Retinal fundus photograph — 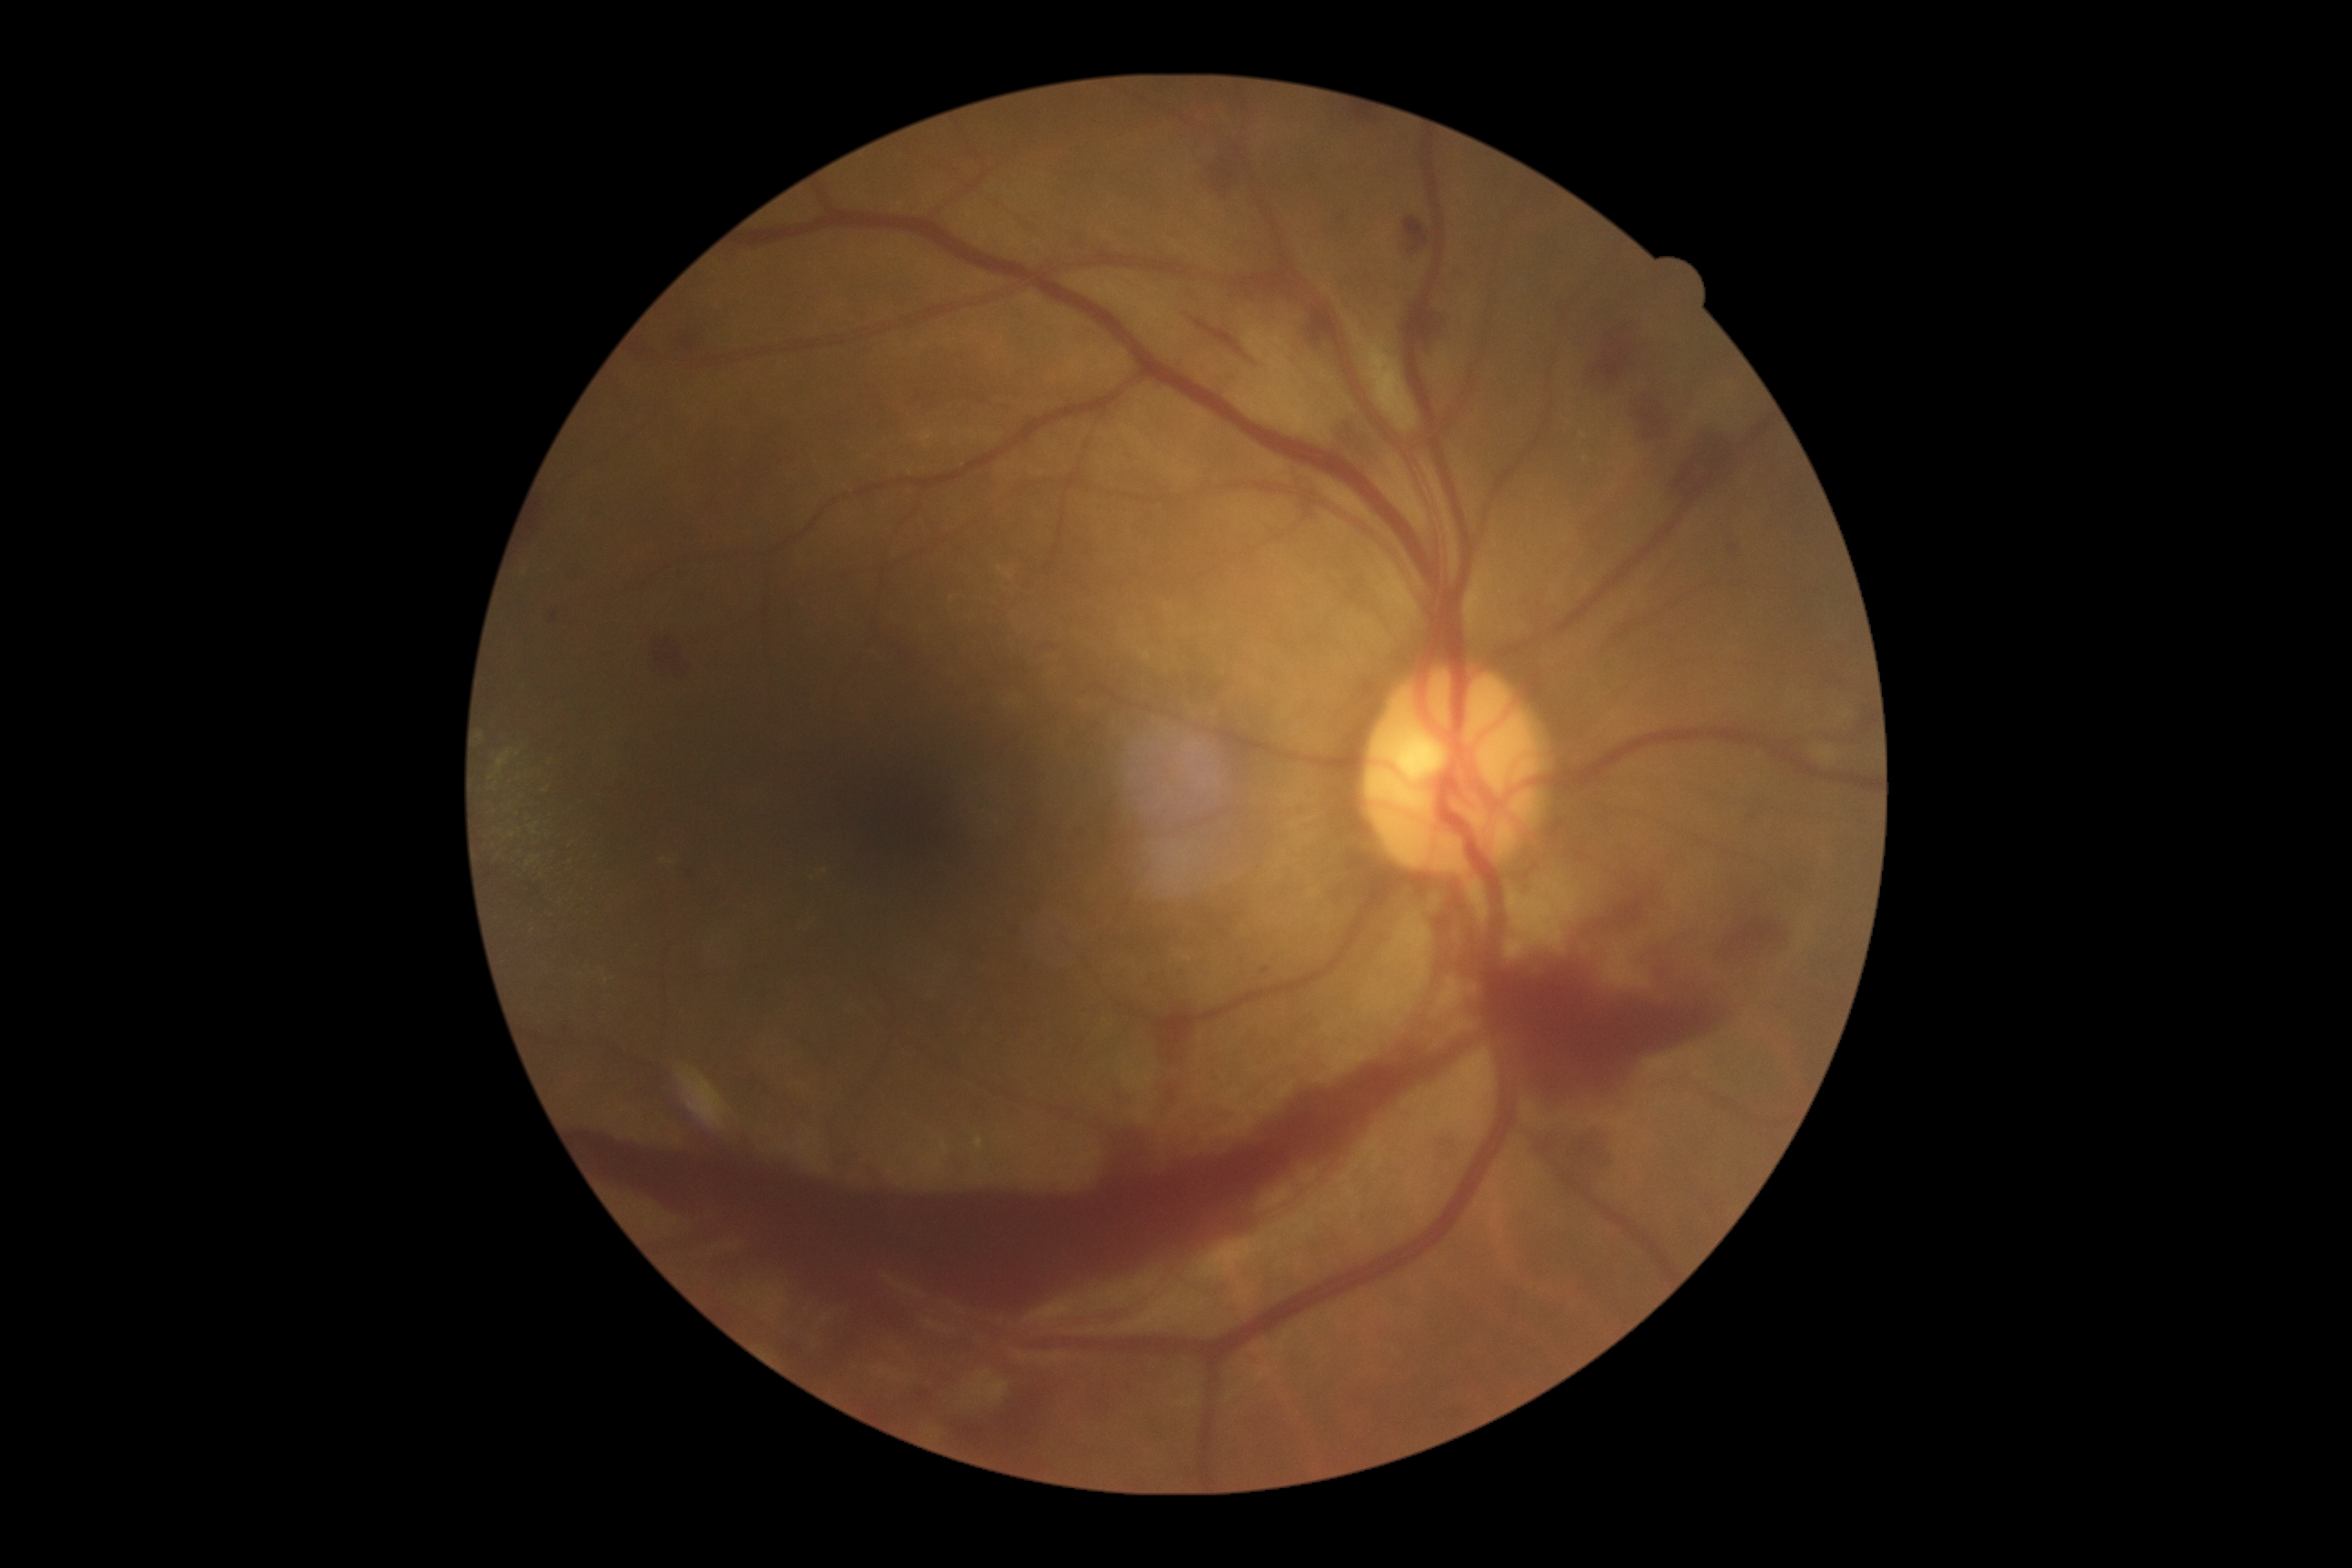
{
  "dr_grade": "grade 4"
}